1380x1382 · color fundus image · 45-degree field of view — 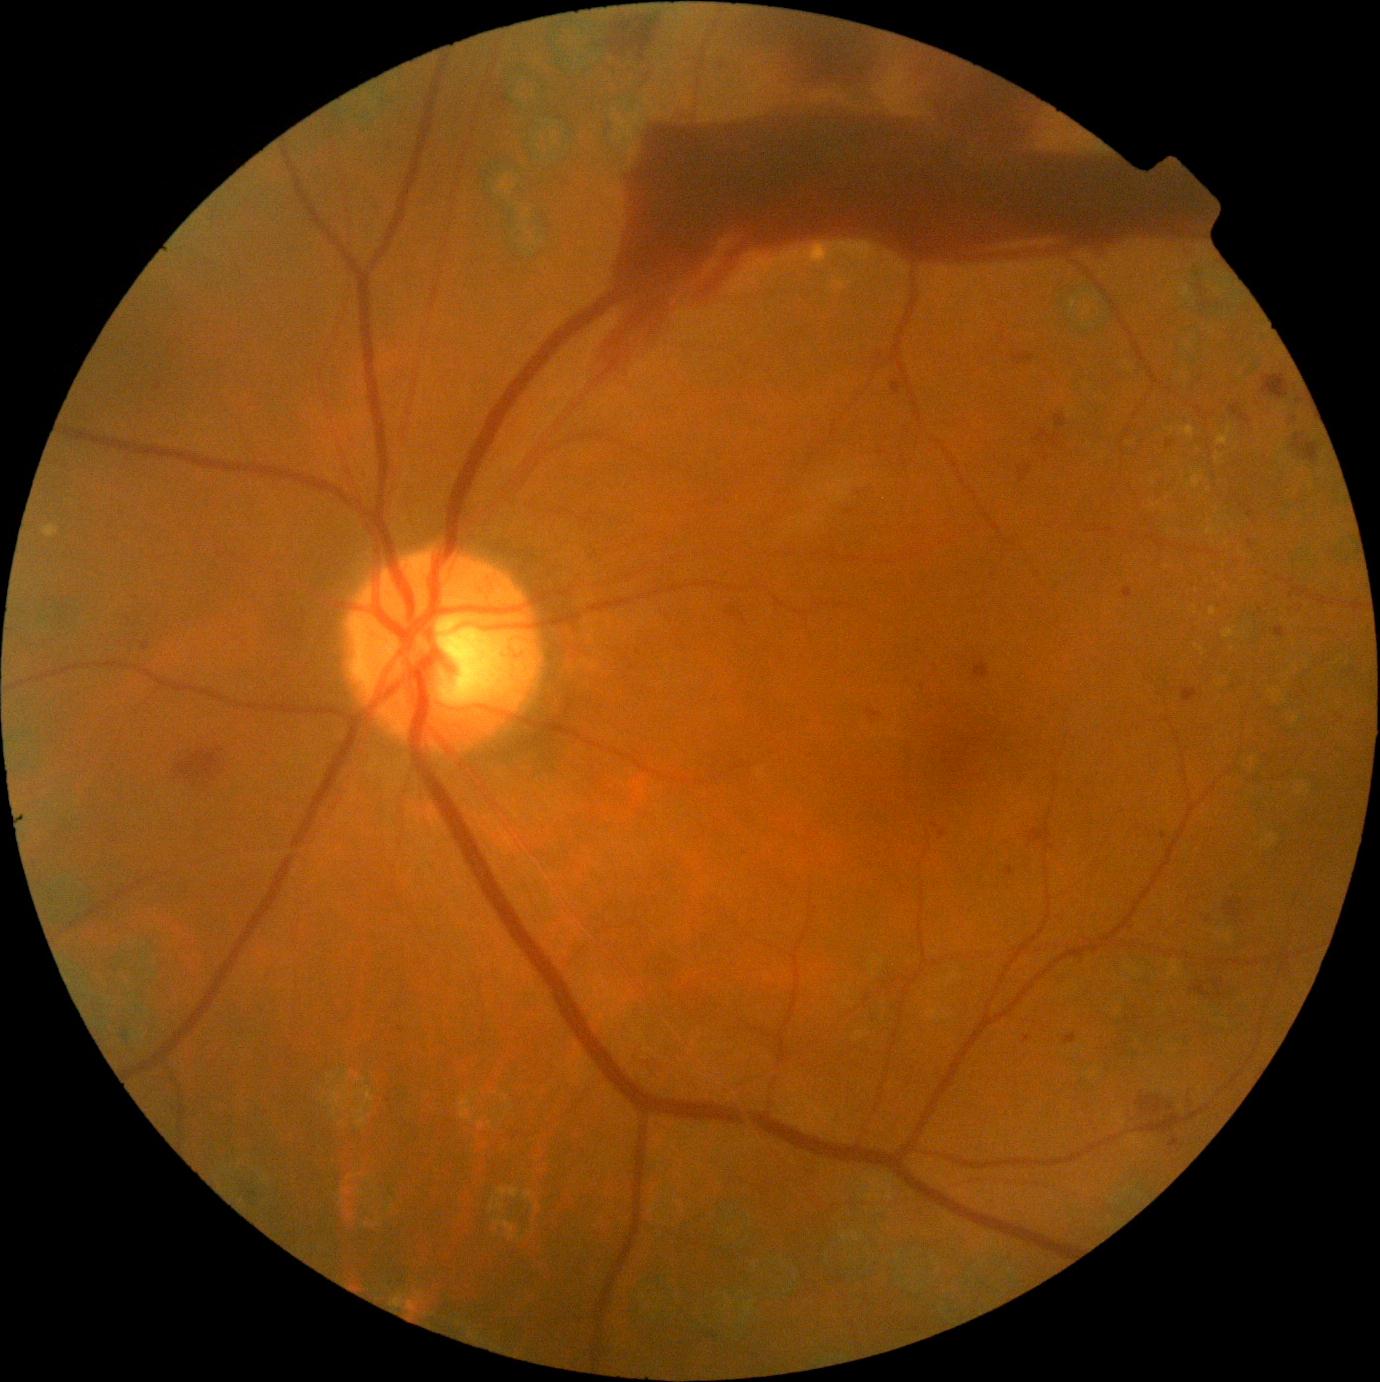 {"partial": true, "dr_grade": 4, "dr_grade_name": "PDR", "lesions": {"ma": [[1275, 628, 1286, 637], [940, 830, 946, 838], [1248, 540, 1255, 548], [1167, 441, 1171, 449], [1248, 509, 1255, 517], [1170, 1139, 1179, 1148], [142, 643, 150, 651], [1123, 587, 1134, 598], [1023, 1036, 1030, 1044], [893, 382, 902, 395], [1287, 419, 1296, 425], [1183, 688, 1198, 702], [1006, 867, 1014, 877], [1065, 1034, 1077, 1044]], "ma_small": [[1292, 595], [935, 825], [879, 358], [1164, 835], [159, 387]], "he": [[1051, 435, 1061, 446], [1263, 375, 1290, 399], [732, 605, 742, 621], [1020, 465, 1029, 481], [1231, 404, 1239, 415], [867, 710, 882, 719], [1140, 1100, 1178, 1125], [1240, 414, 1252, 425], [173, 750, 221, 785], [1014, 355, 1034, 365], [1055, 415, 1066, 427], [1292, 434, 1321, 464], [1029, 827, 1053, 843], [595, 25, 1209, 383], [1222, 897, 1241, 920], [1039, 429, 1050, 440], [1198, 979, 1228, 999], [610, 12, 657, 63], [975, 661, 989, 679]], "se": null, "ex": [[1217, 427, 1233, 446], [1191, 474, 1203, 489], [1181, 426, 1196, 438], [1166, 429, 1174, 434], [44, 526, 59, 538], [810, 247, 821, 256], [1194, 644, 1205, 653], [1223, 629, 1235, 639], [1215, 453, 1224, 465], [1210, 608, 1217, 616]], "ex_small": [[1209, 490], [1188, 486]]}}